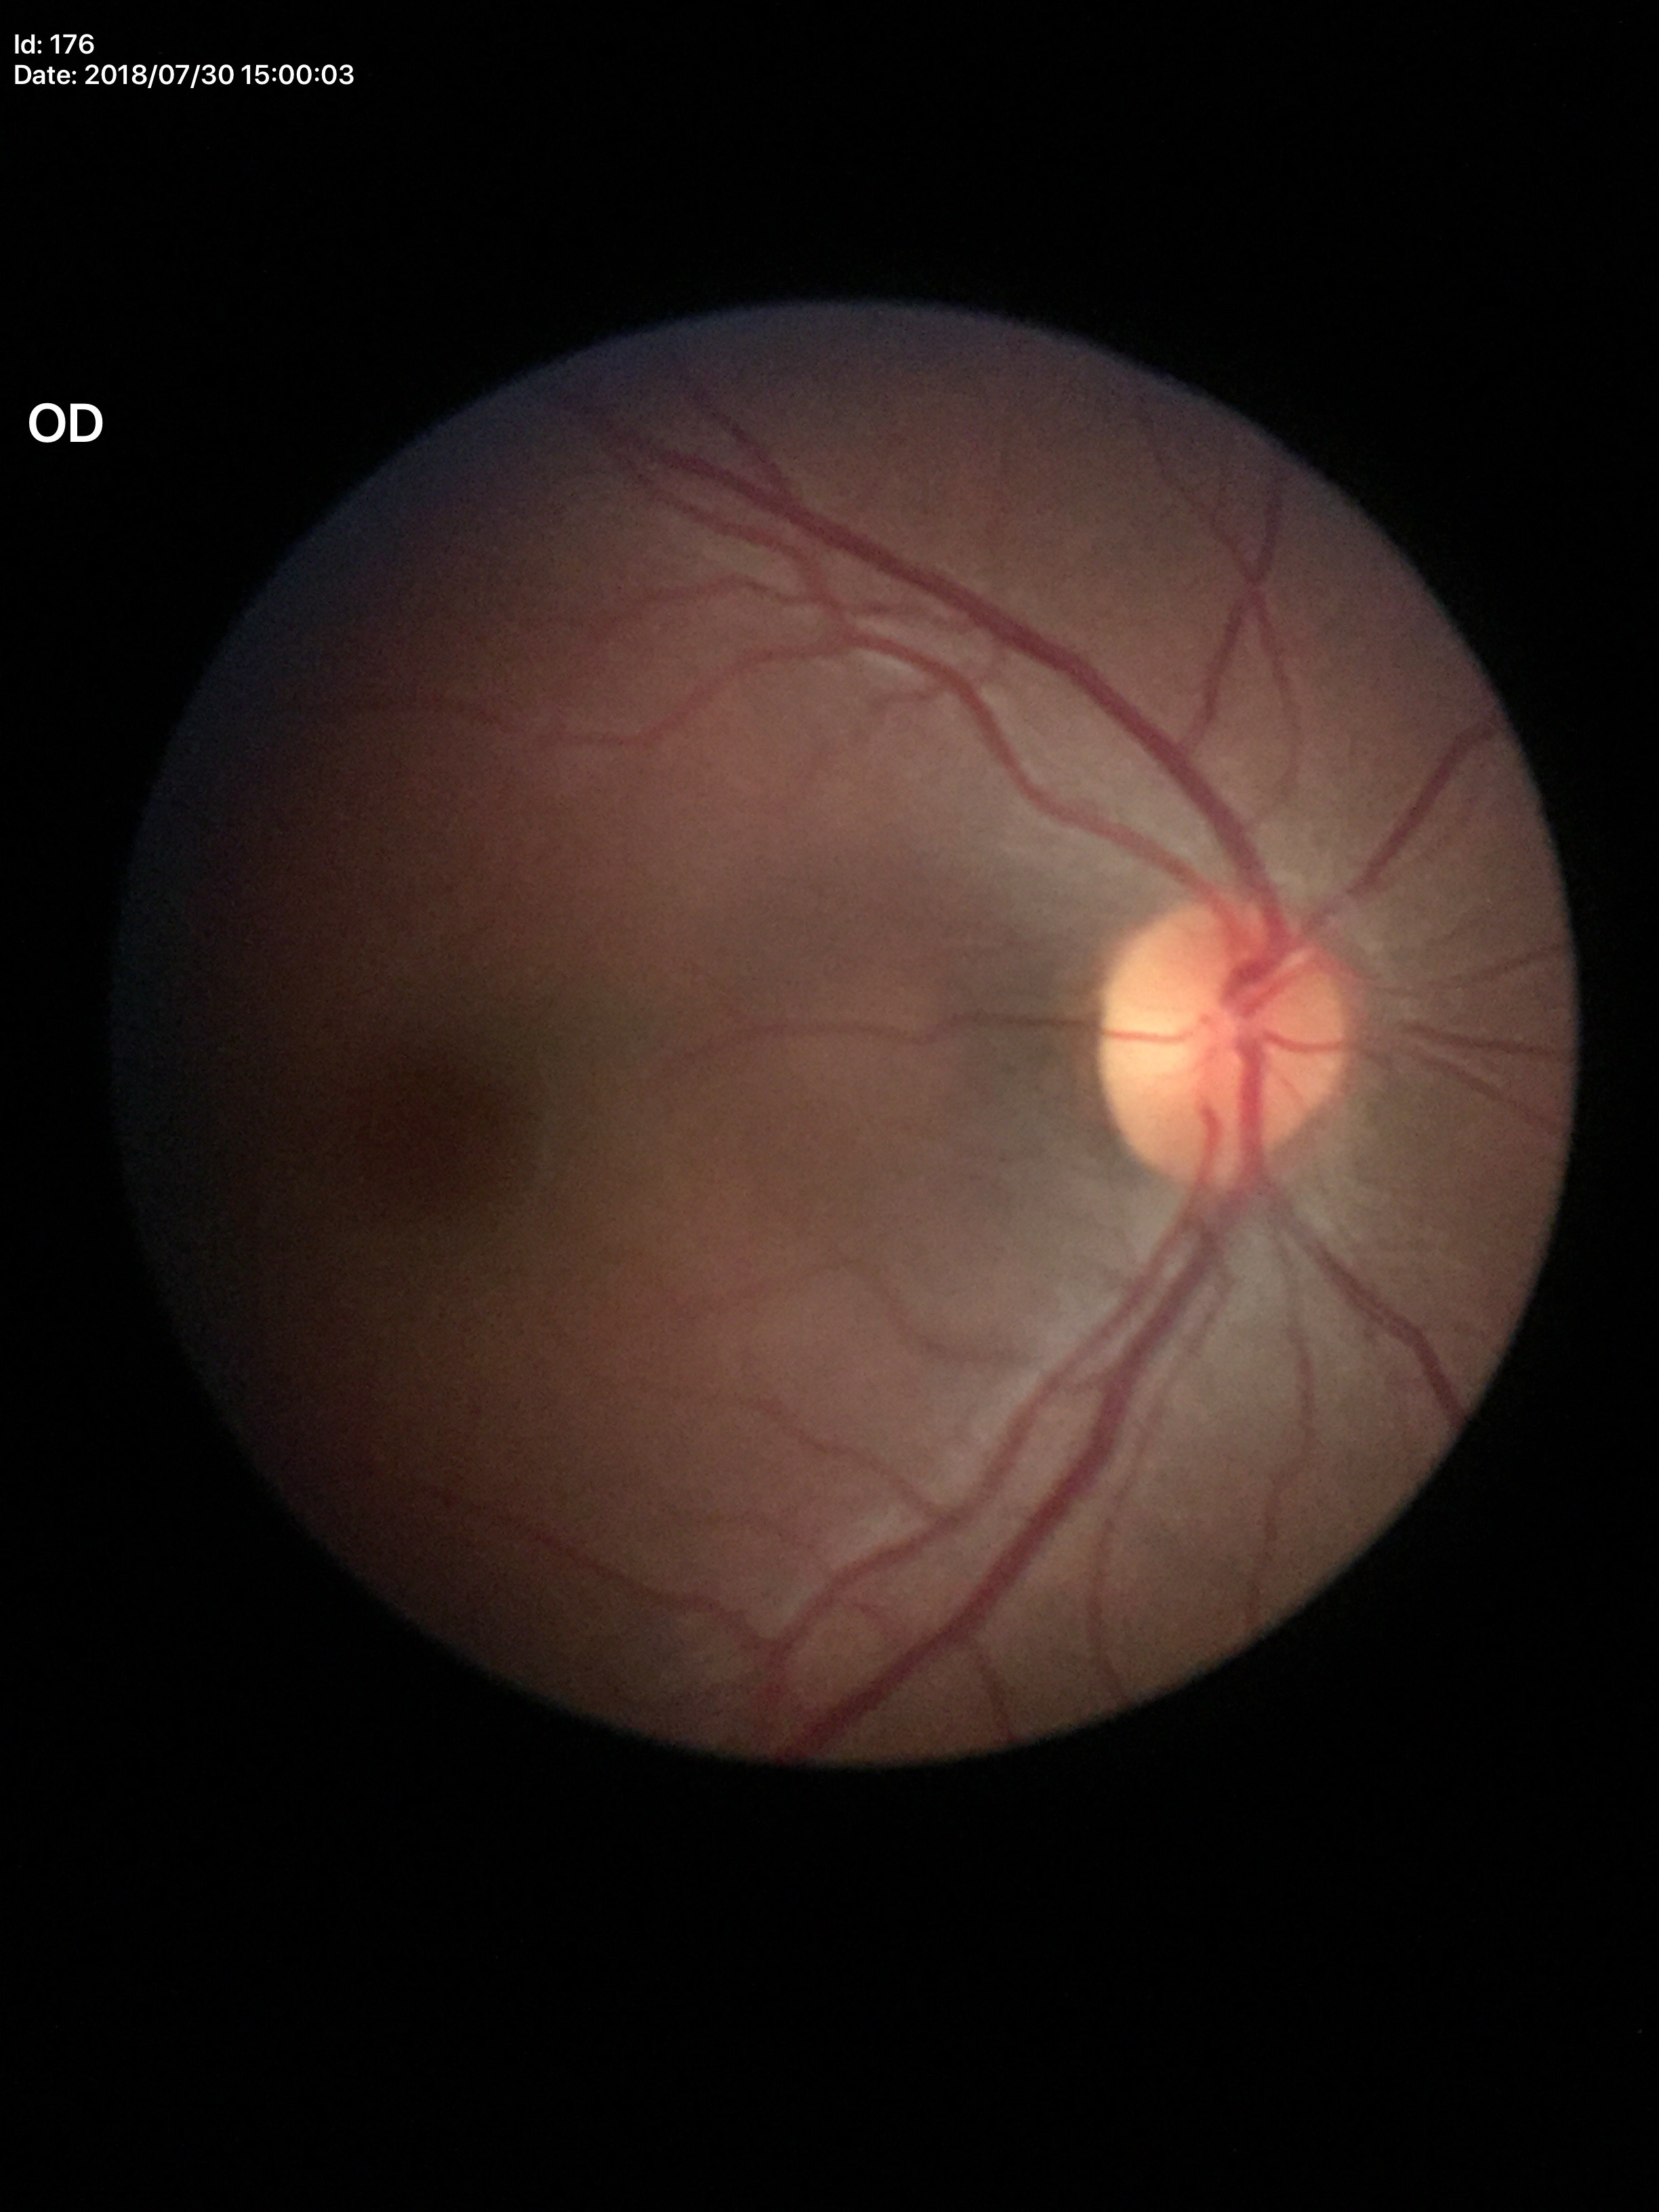

vertical CDR: 0.48, Glaucoma impression: no suspicious findings.